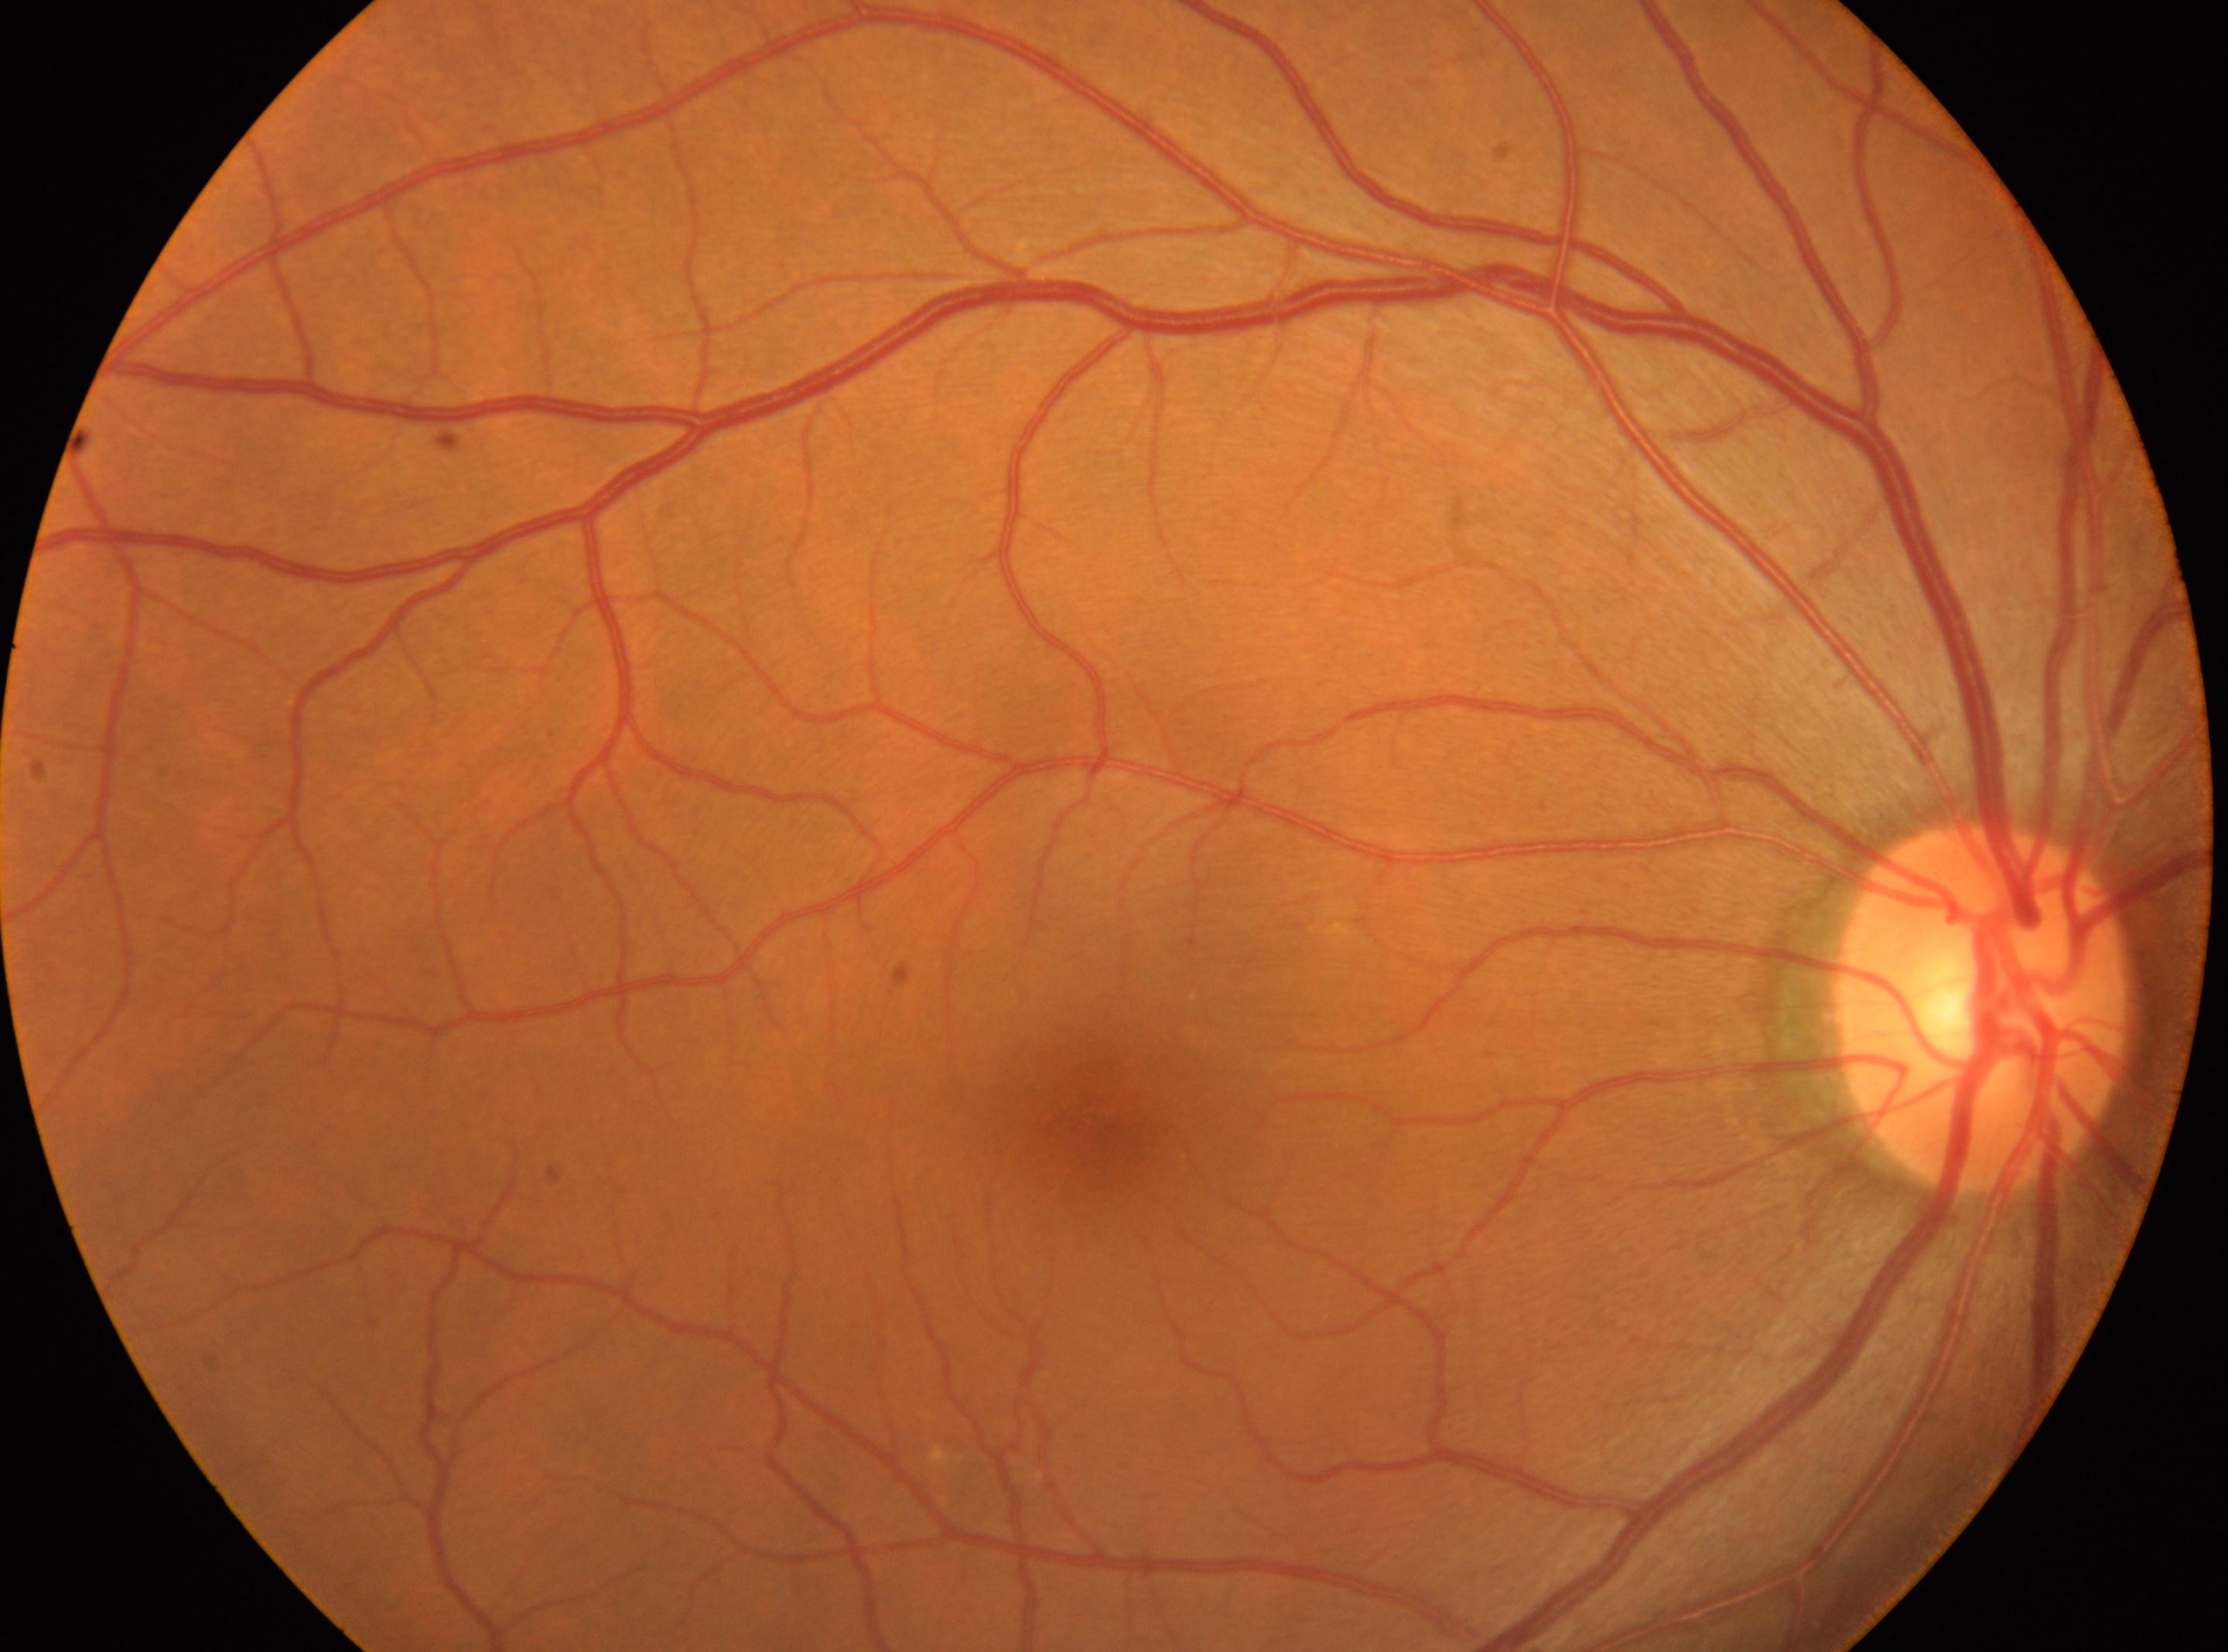

No DR findings.
DR grade is 0.
The optic disc is at (1982,1010).
Fovea center located at (1103,1125).
This is the right eye.